RetCam wide-field infant fundus image · Clarity RetCam 3, 130° FOV · 640x480.
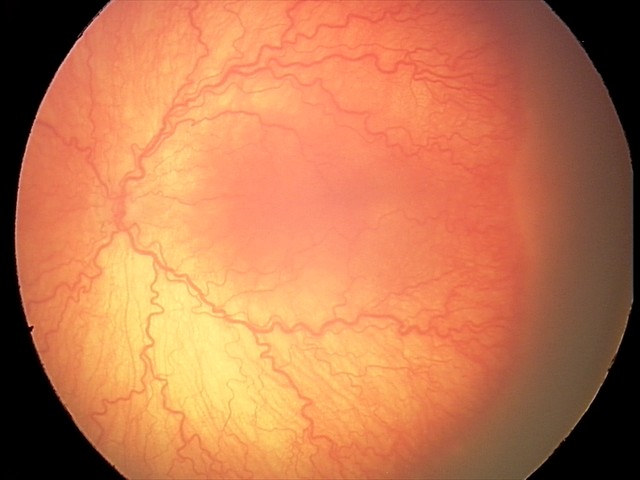
Screening: aggressive retinopathy of prematurity (A-ROP); plus disease.